2352x1568 · 45° FOV.
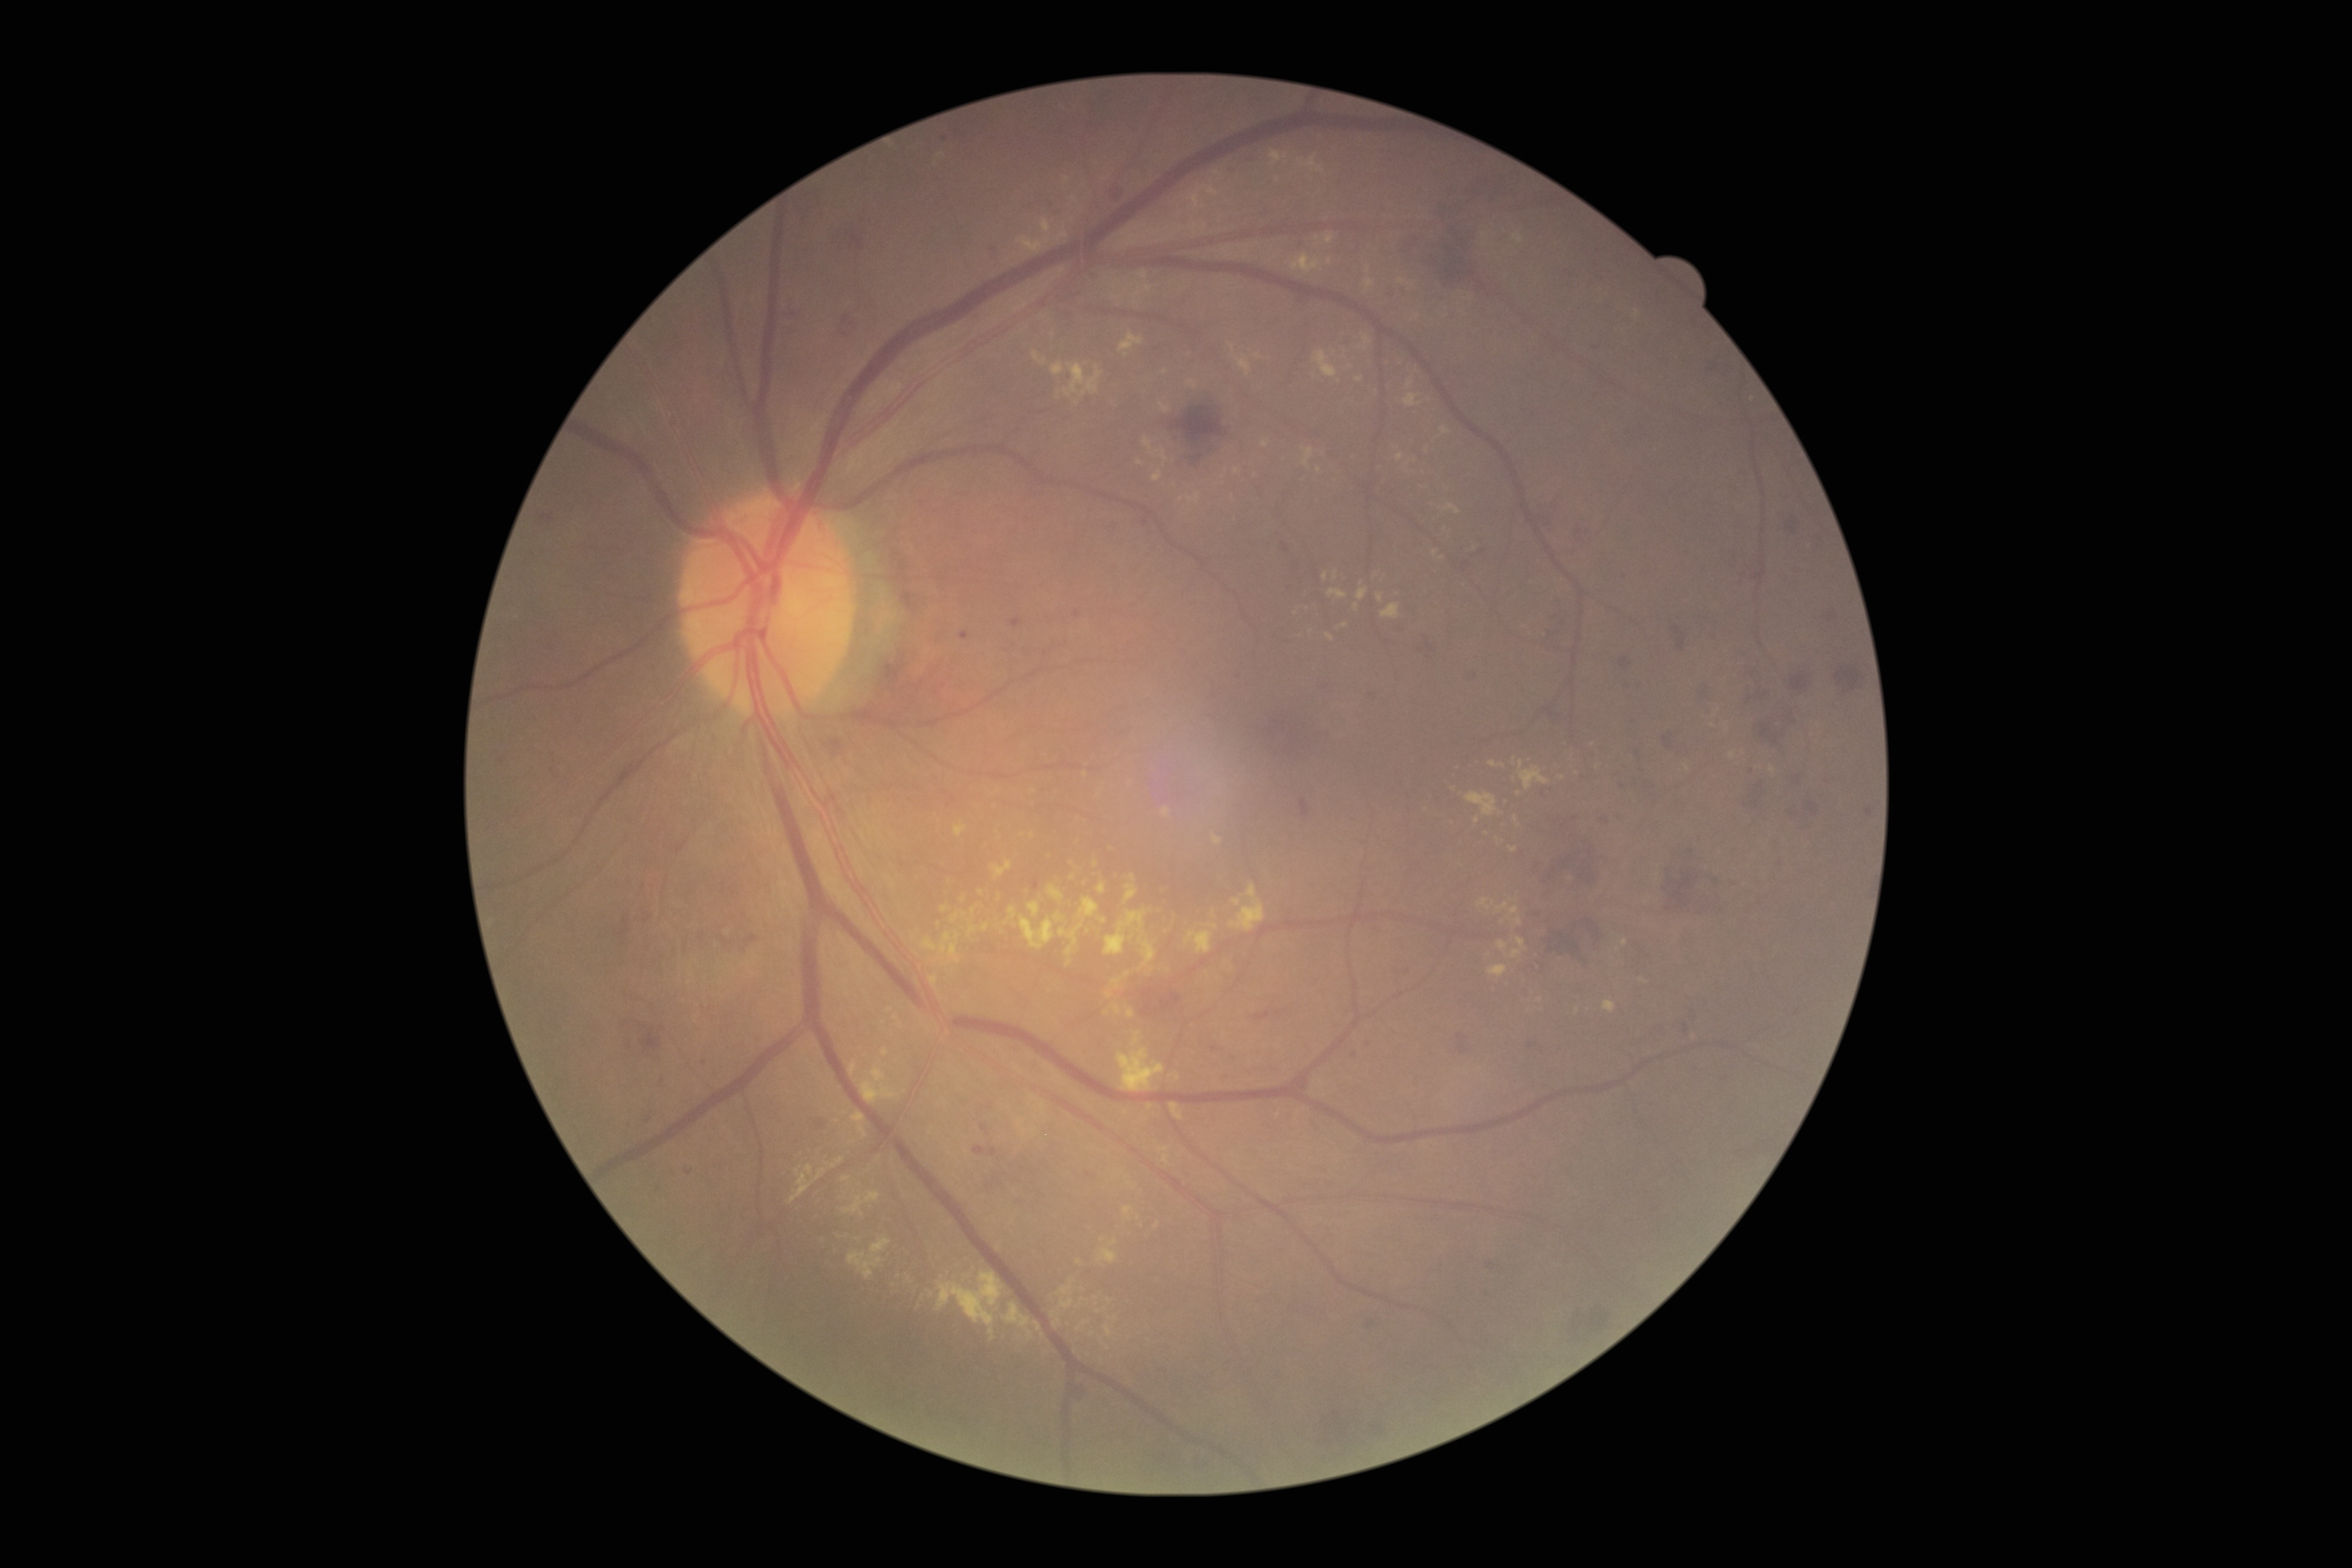

{"partial": true, "dr_grade": 2, "dr_grade_name": "moderate NPDR", "lesions": {"ex": [[1129, 873, 1135, 881], [1495, 902, 1523, 926], [1212, 833, 1221, 844], [1189, 187, 1206, 211], [1059, 232, 1069, 239], [1302, 447, 1313, 468], [1406, 377, 1414, 389], [1133, 1030, 1143, 1047], [1063, 362, 1103, 397], [1203, 222, 1207, 230], [1357, 589, 1368, 601]], "ex_small_centers": [[1236, 472], [1325, 576], [1493, 903], [931, 1293], [963, 899], [1213, 912], [1140, 463]]}}